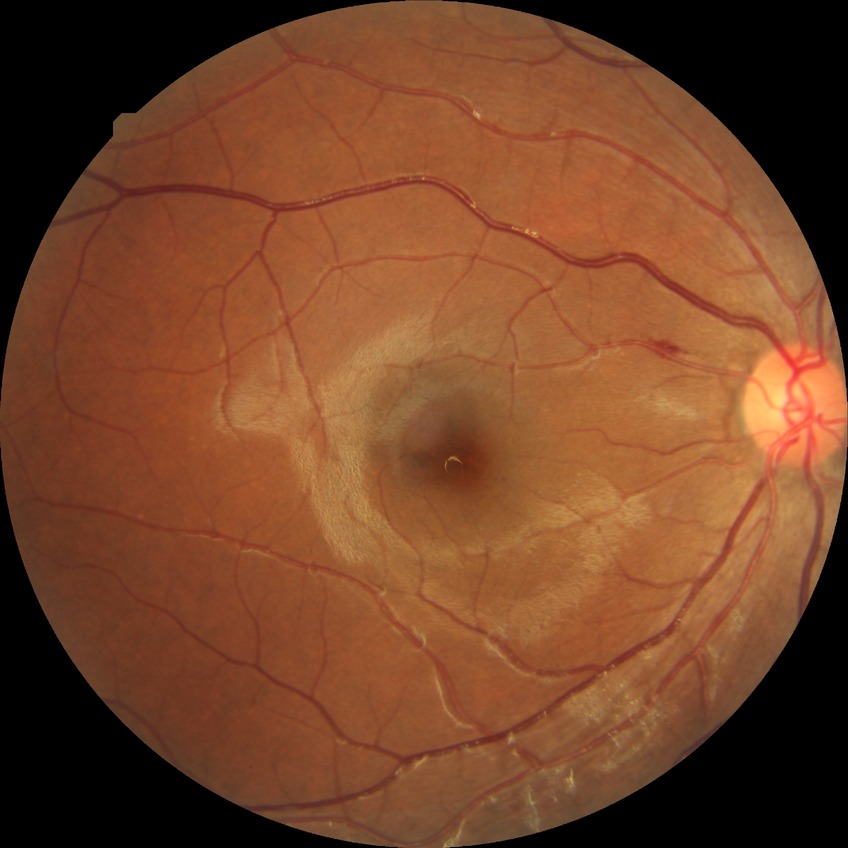 Davis grading = simple diabetic retinopathy.